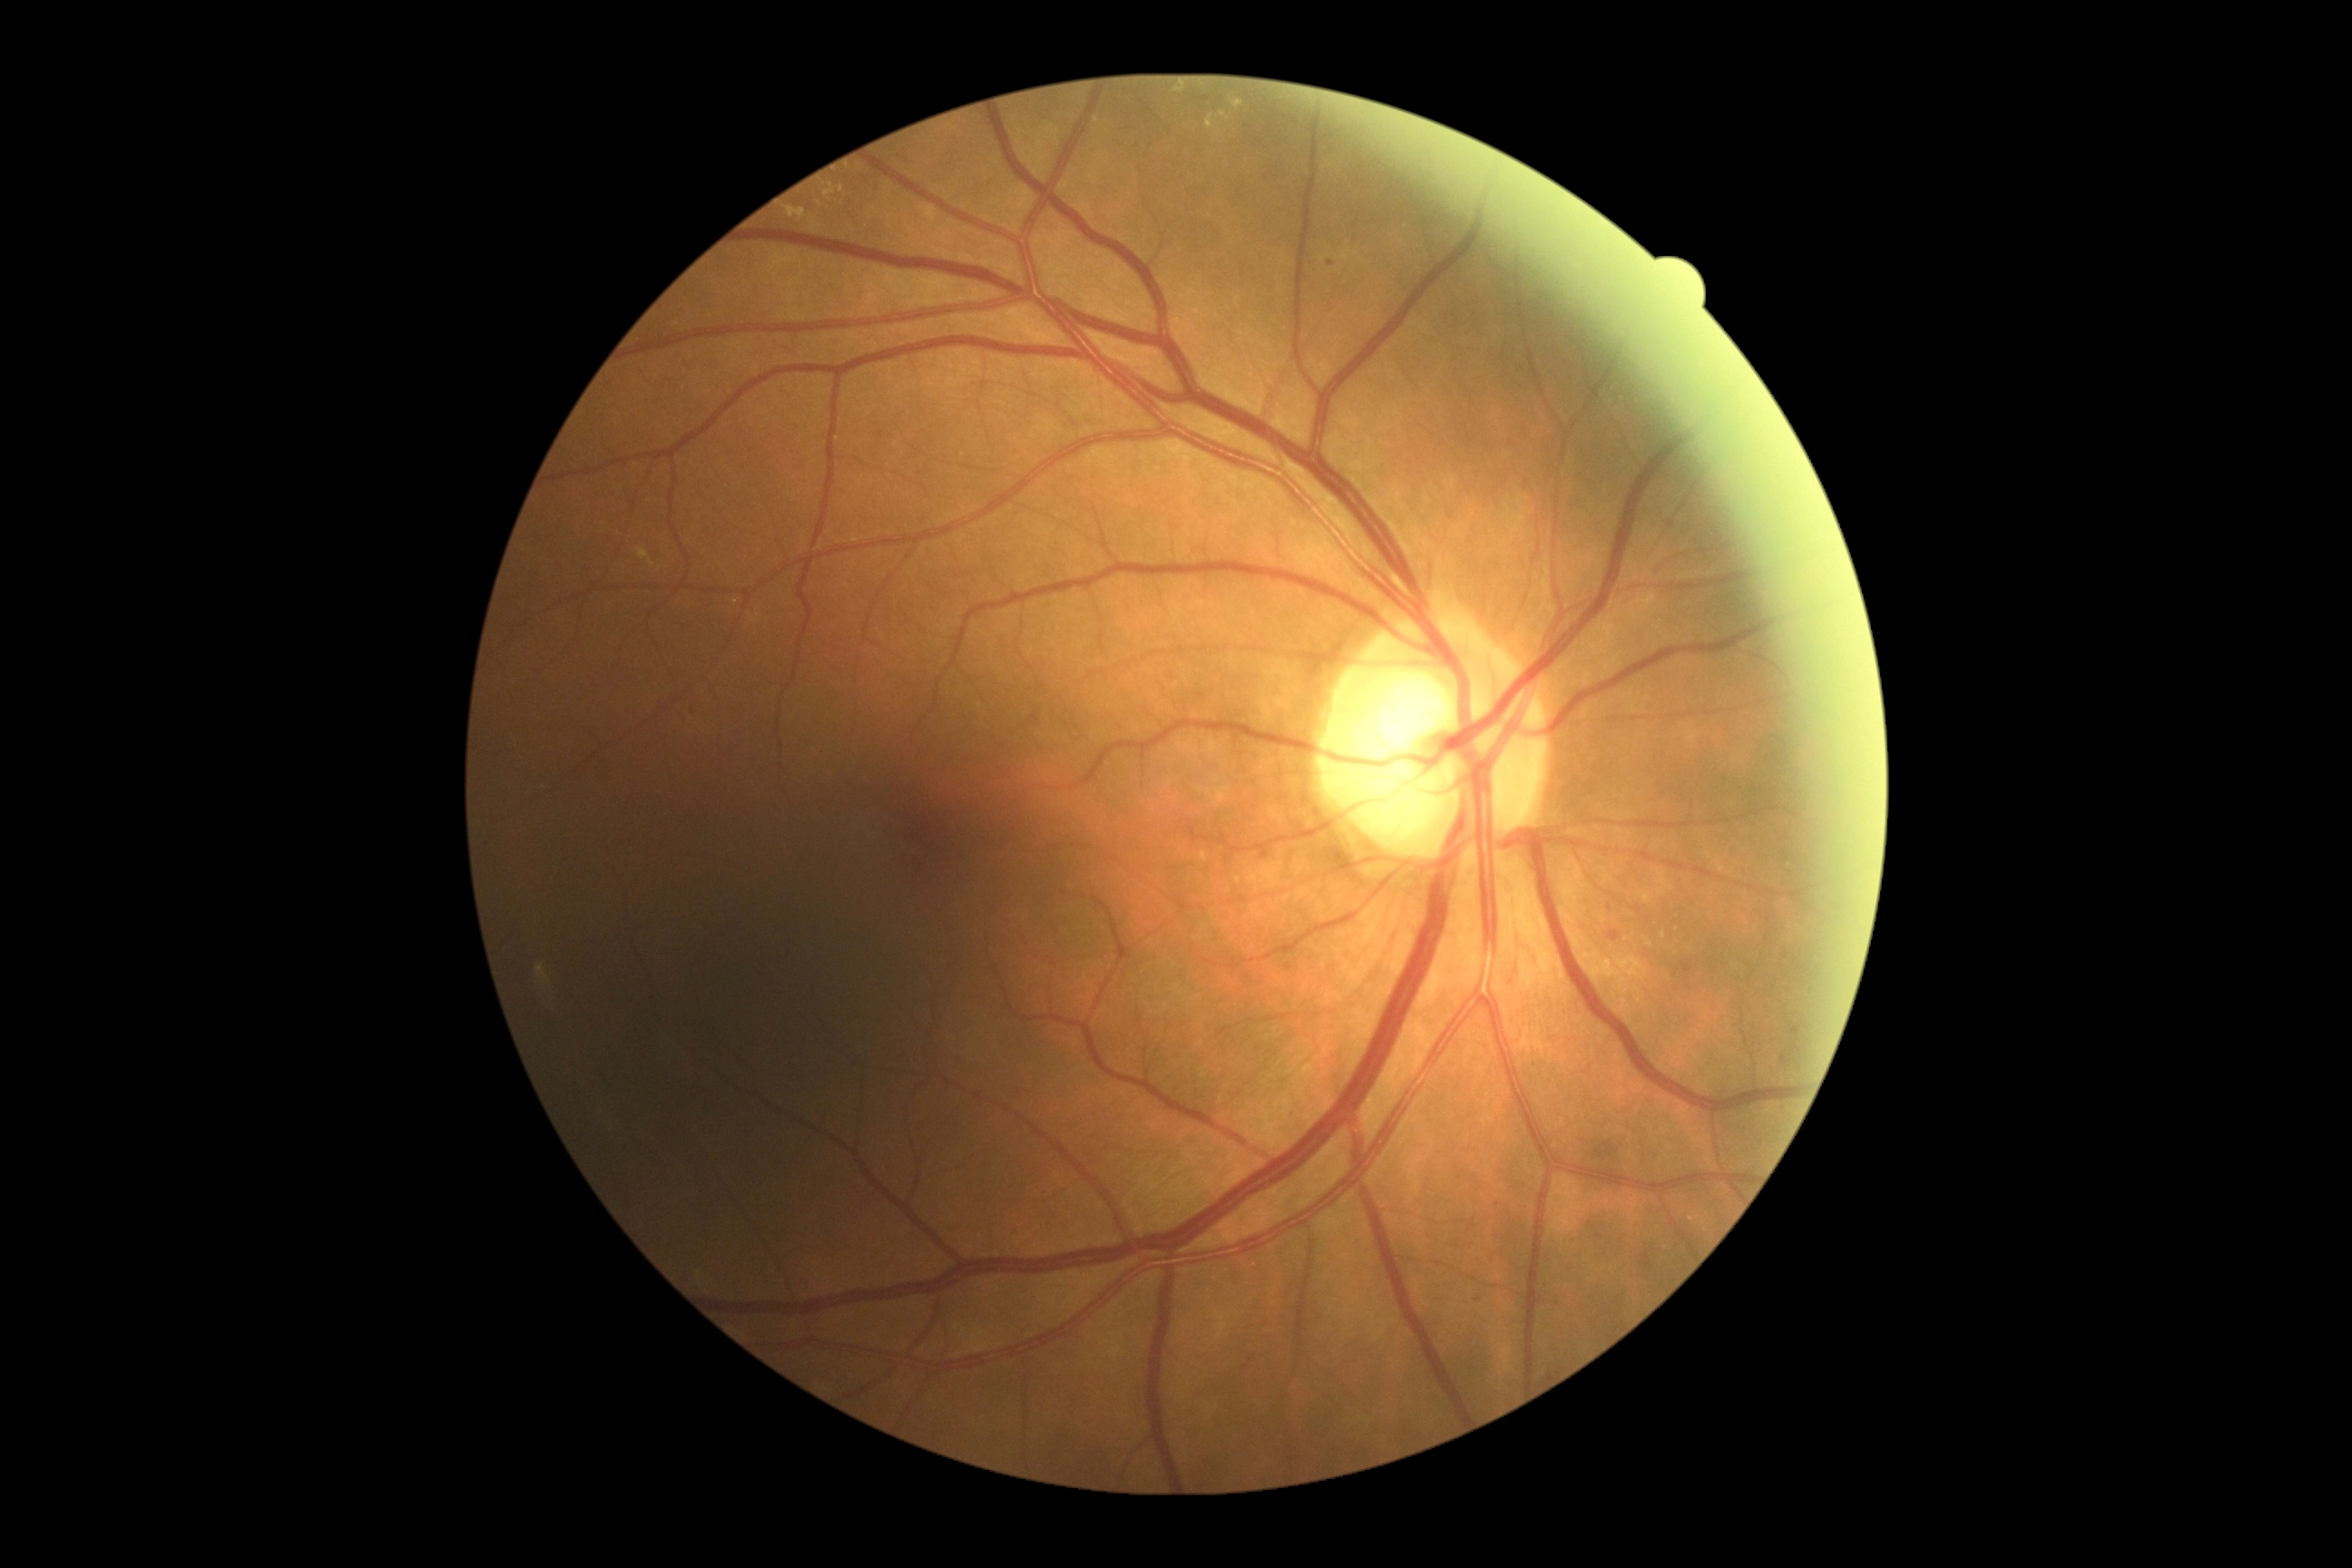 DR class = non-proliferative diabetic retinopathy; retinopathy = grade 2.